Posterior pole color fundus photograph: 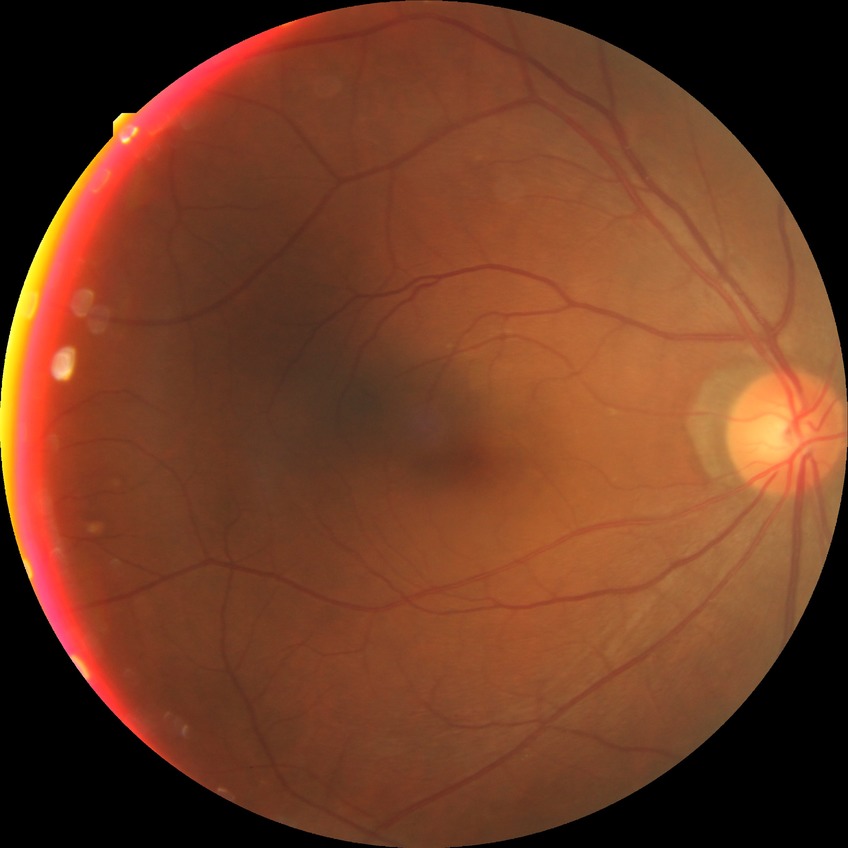 Diabetic retinopathy (DR) is NDR (no diabetic retinopathy).